Graded on the modified Davis scale; without pupil dilation
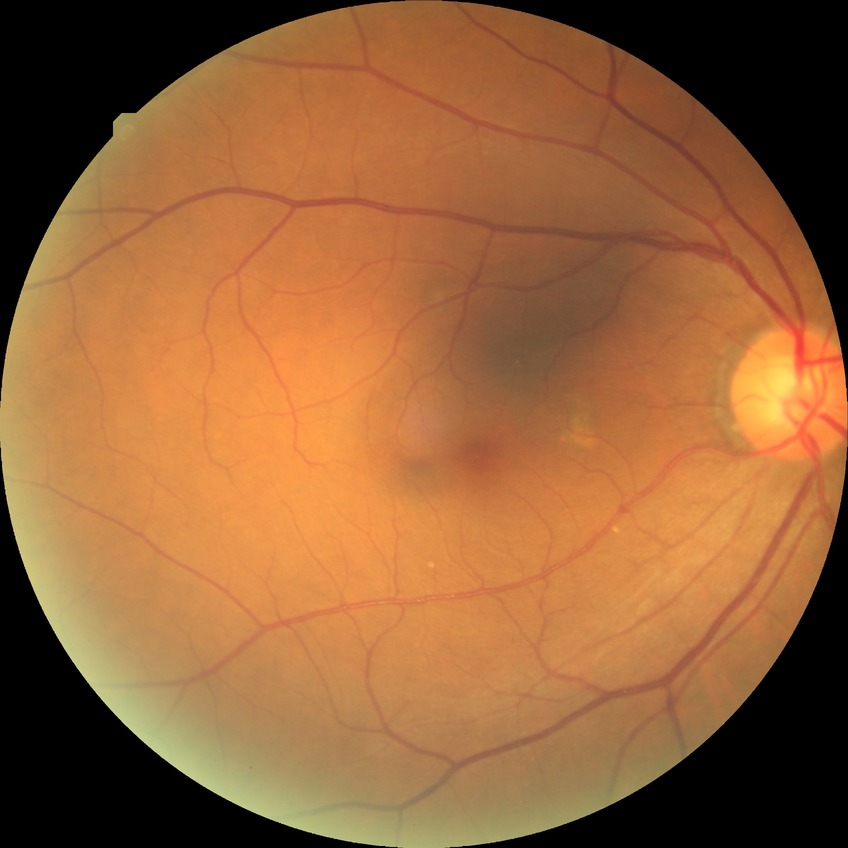

diabetic retinopathy (DR) = no diabetic retinopathy (NDR).